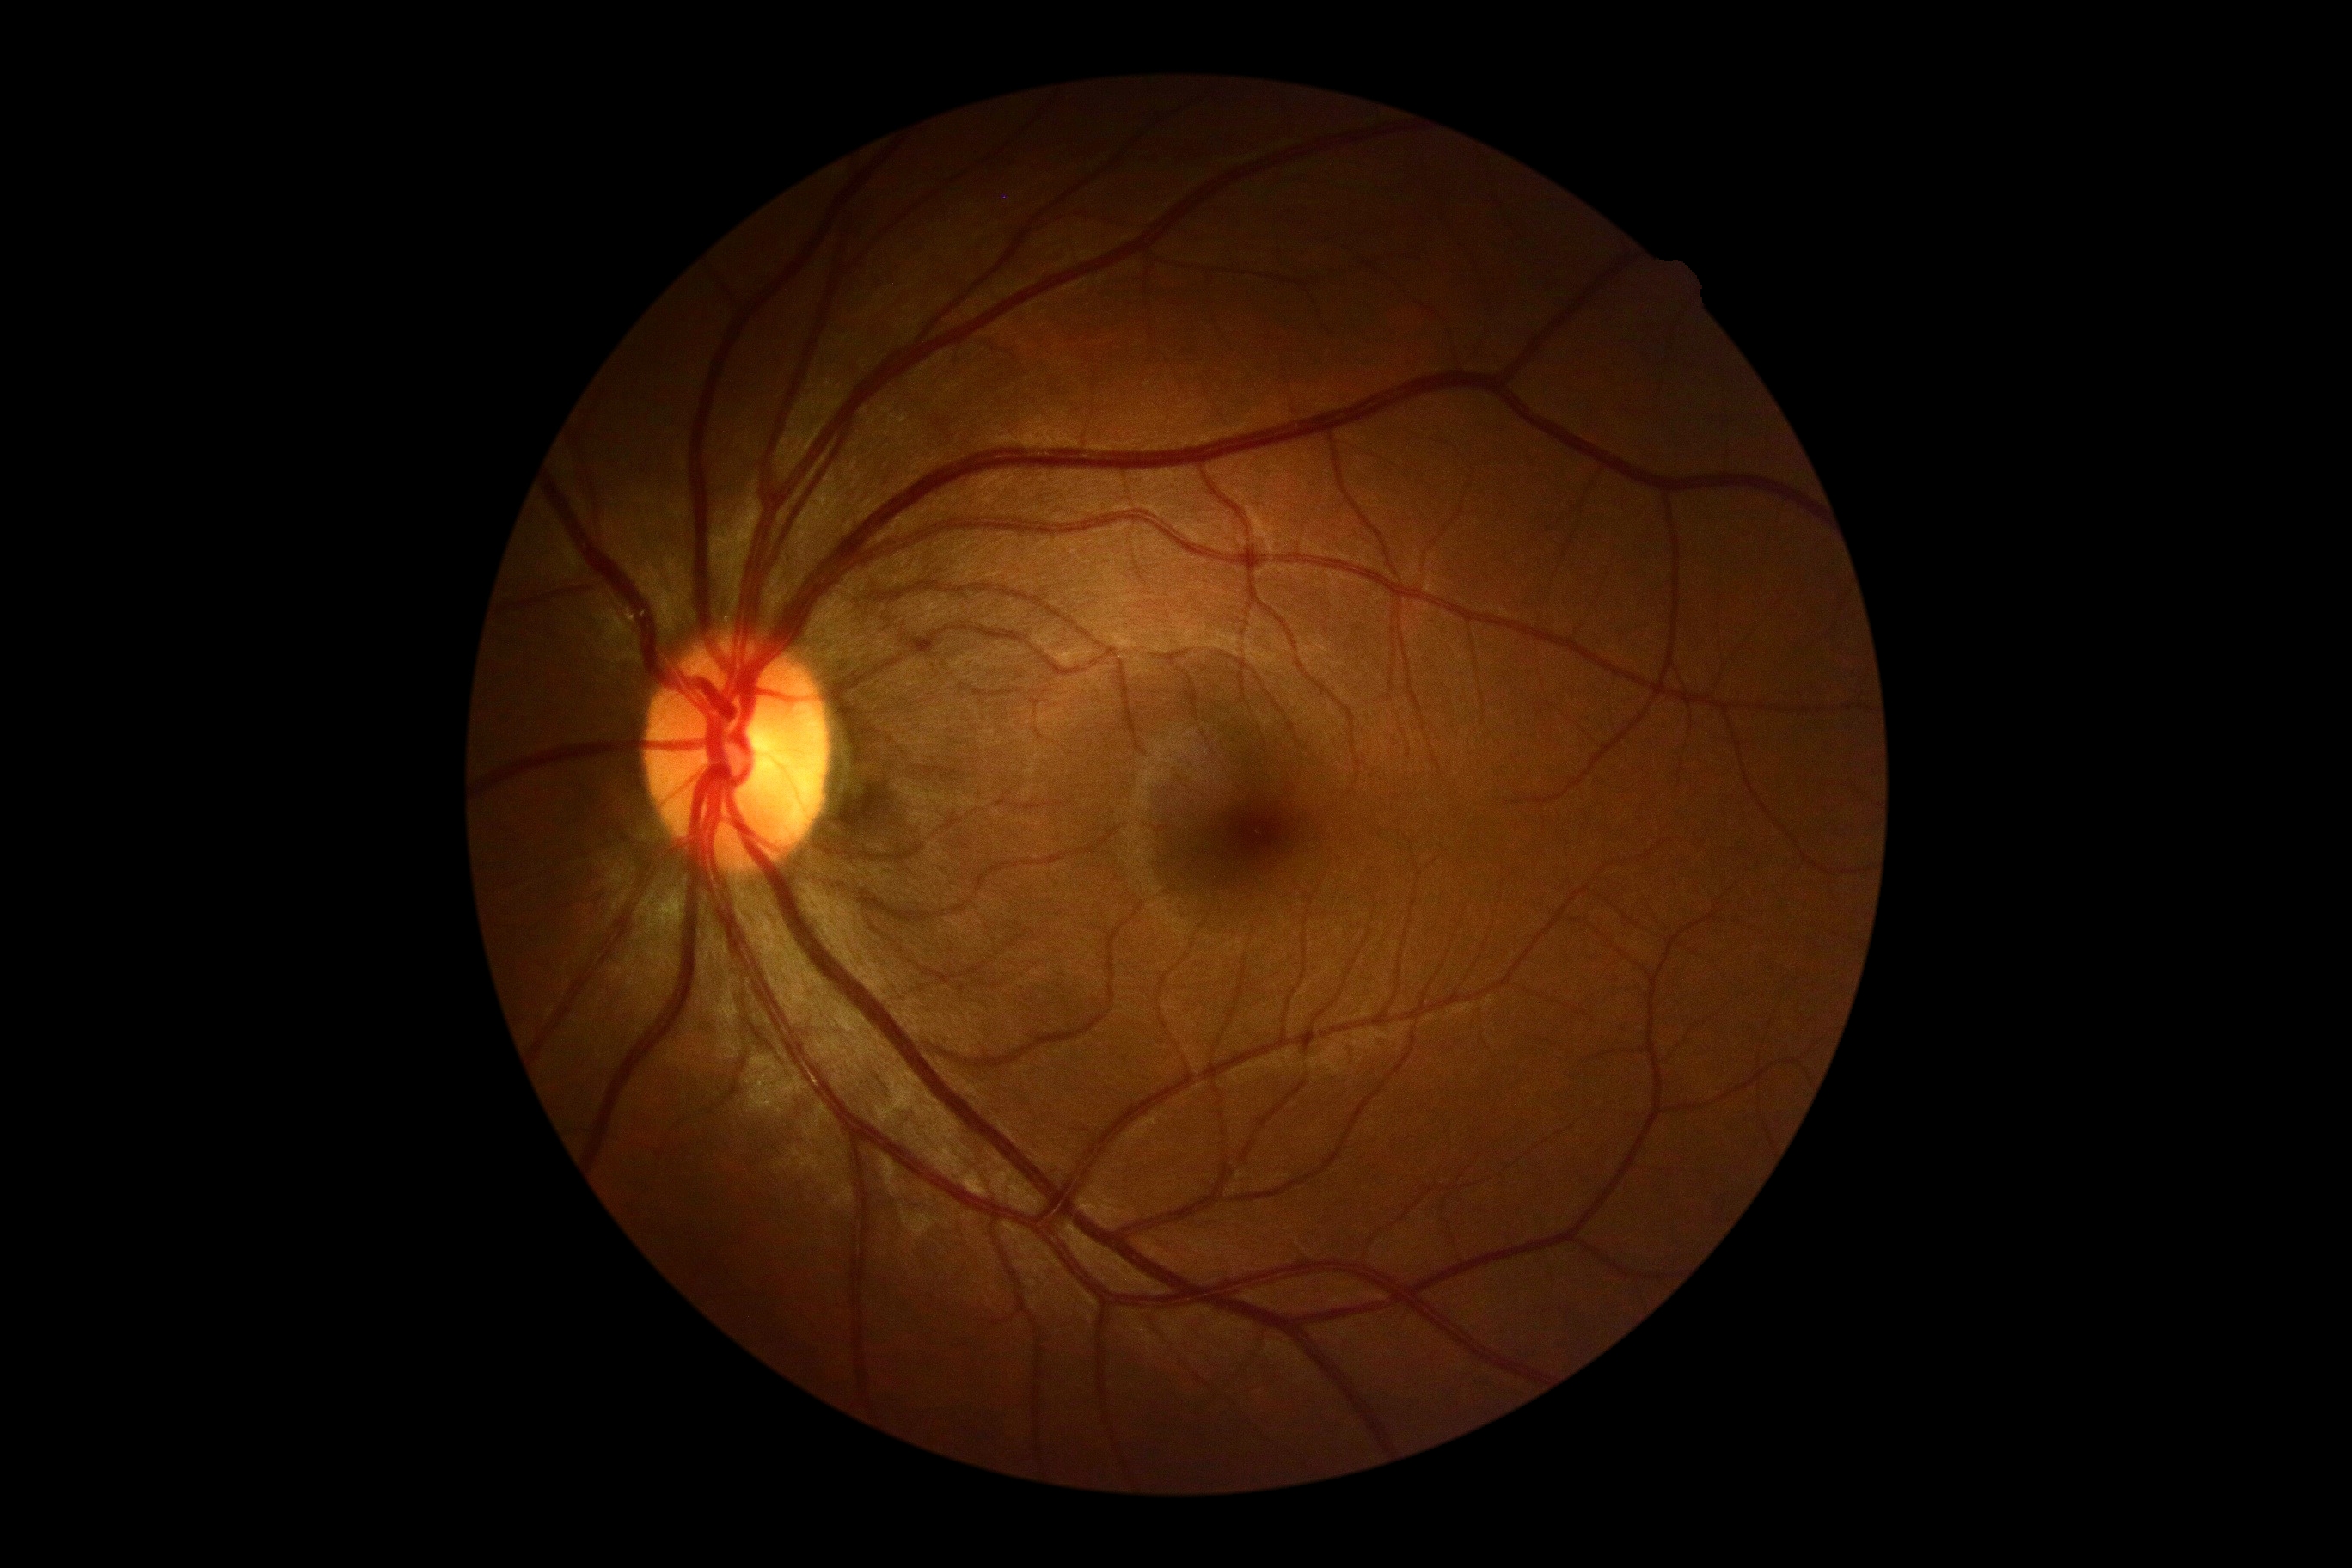 {"dr_grade": "no apparent retinopathy (grade 0)"}